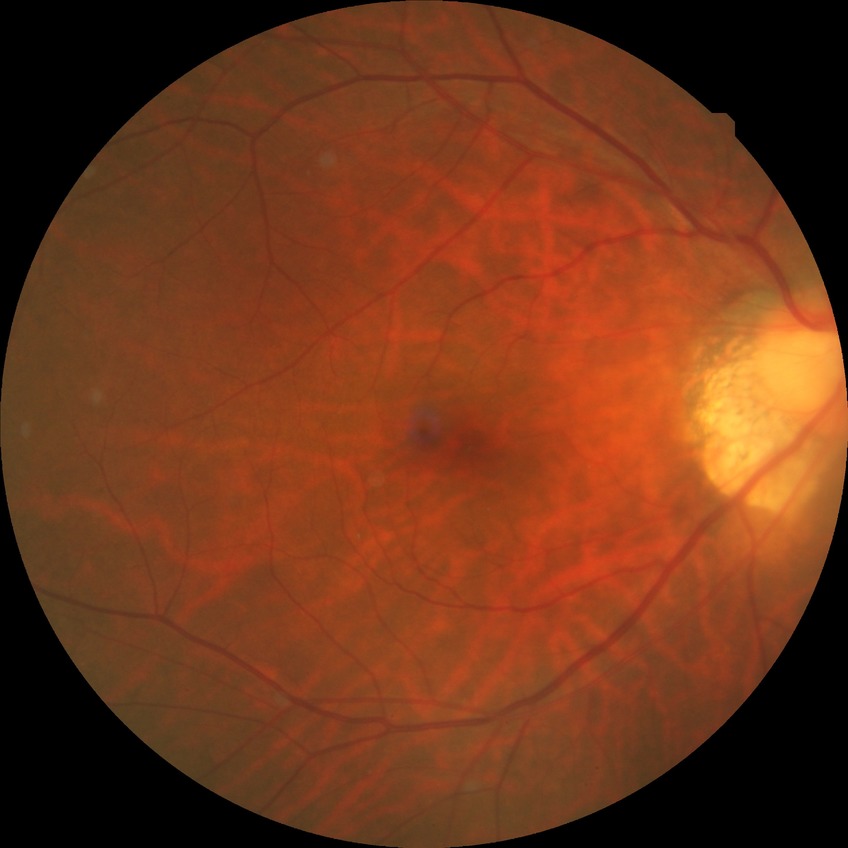 Diabetic retinopathy severity: no diabetic retinopathy.